45-degree field of view · without pupil dilation · NIDEK AFC-230 fundus camera · 848x848 — 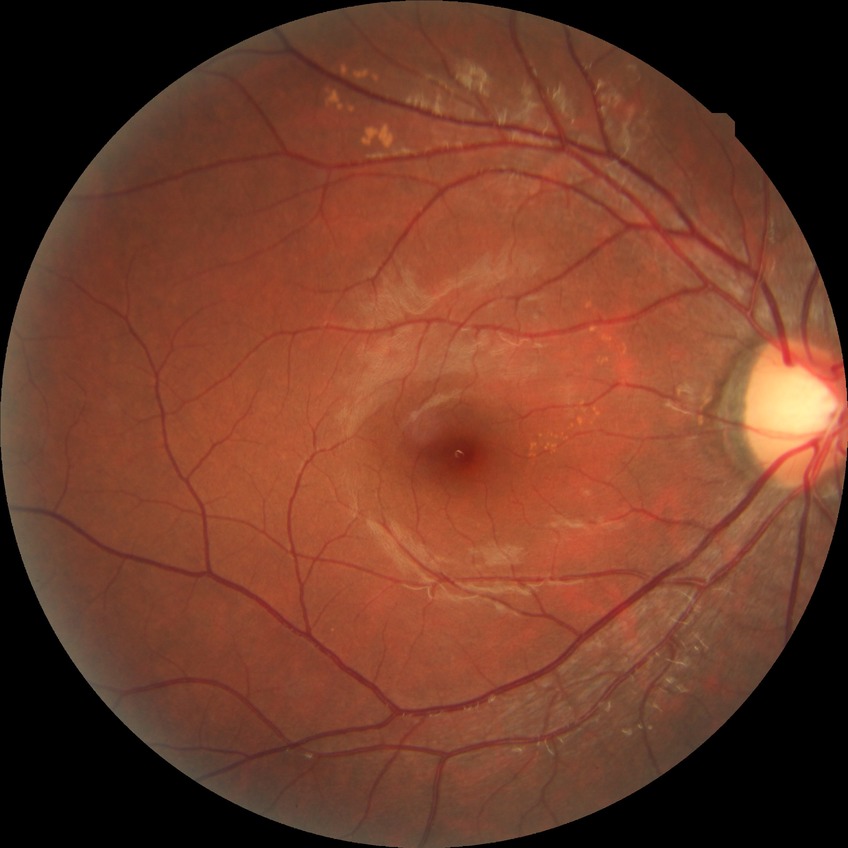
Davis DR grade: NDR.